2048x1536px — 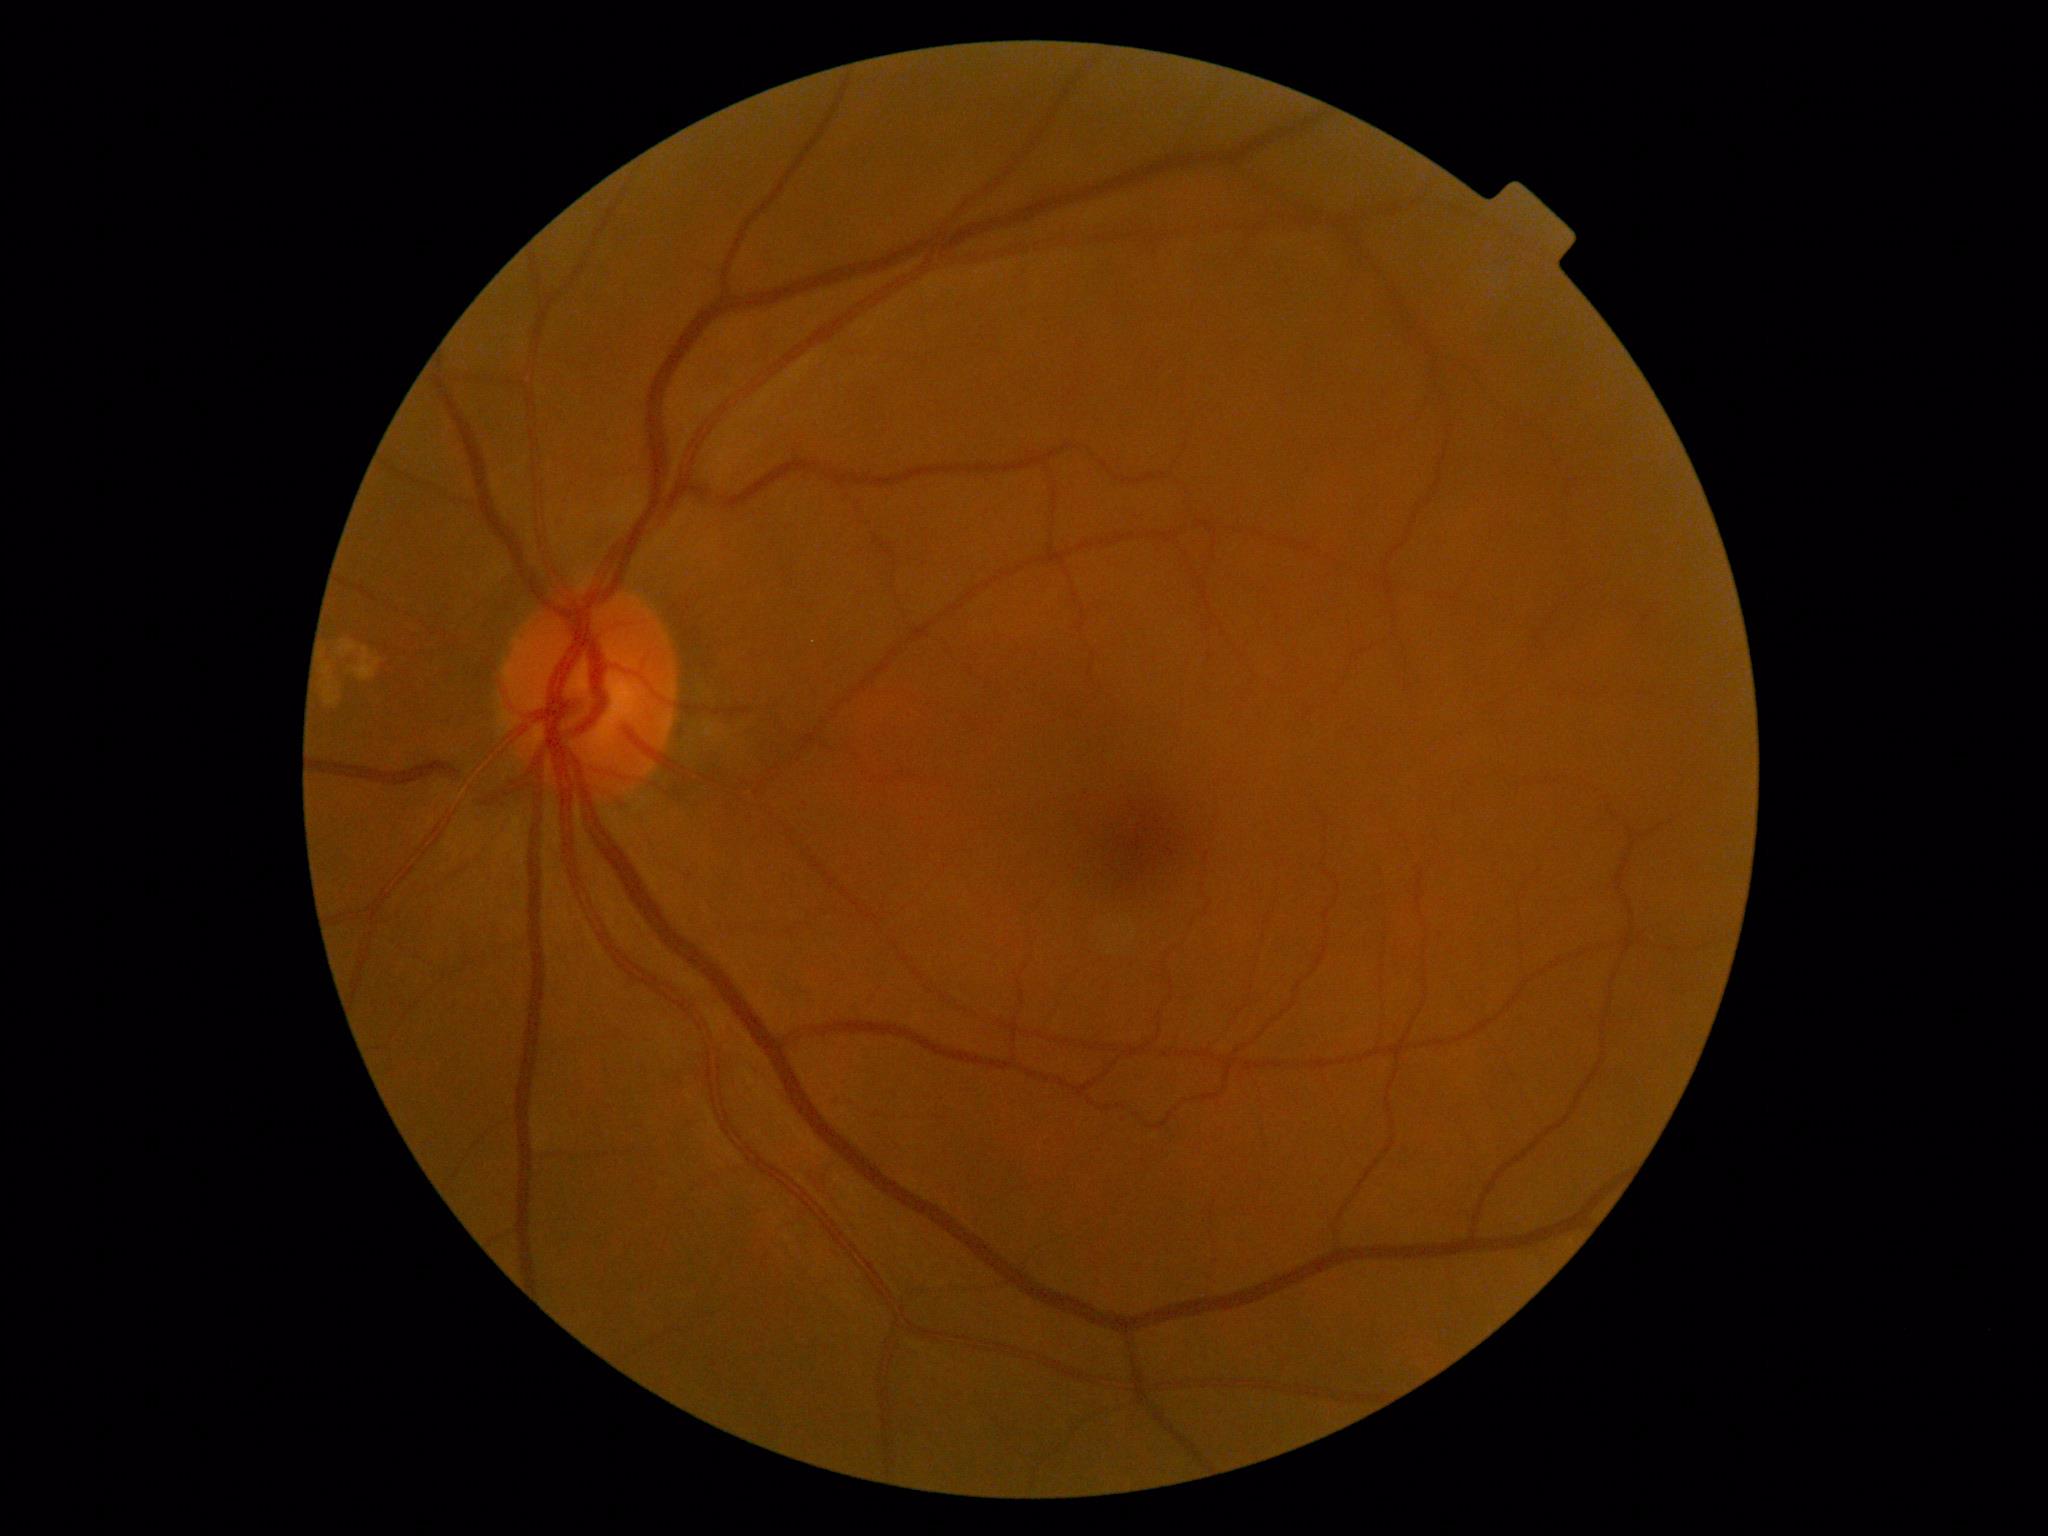   dr_grade: 0